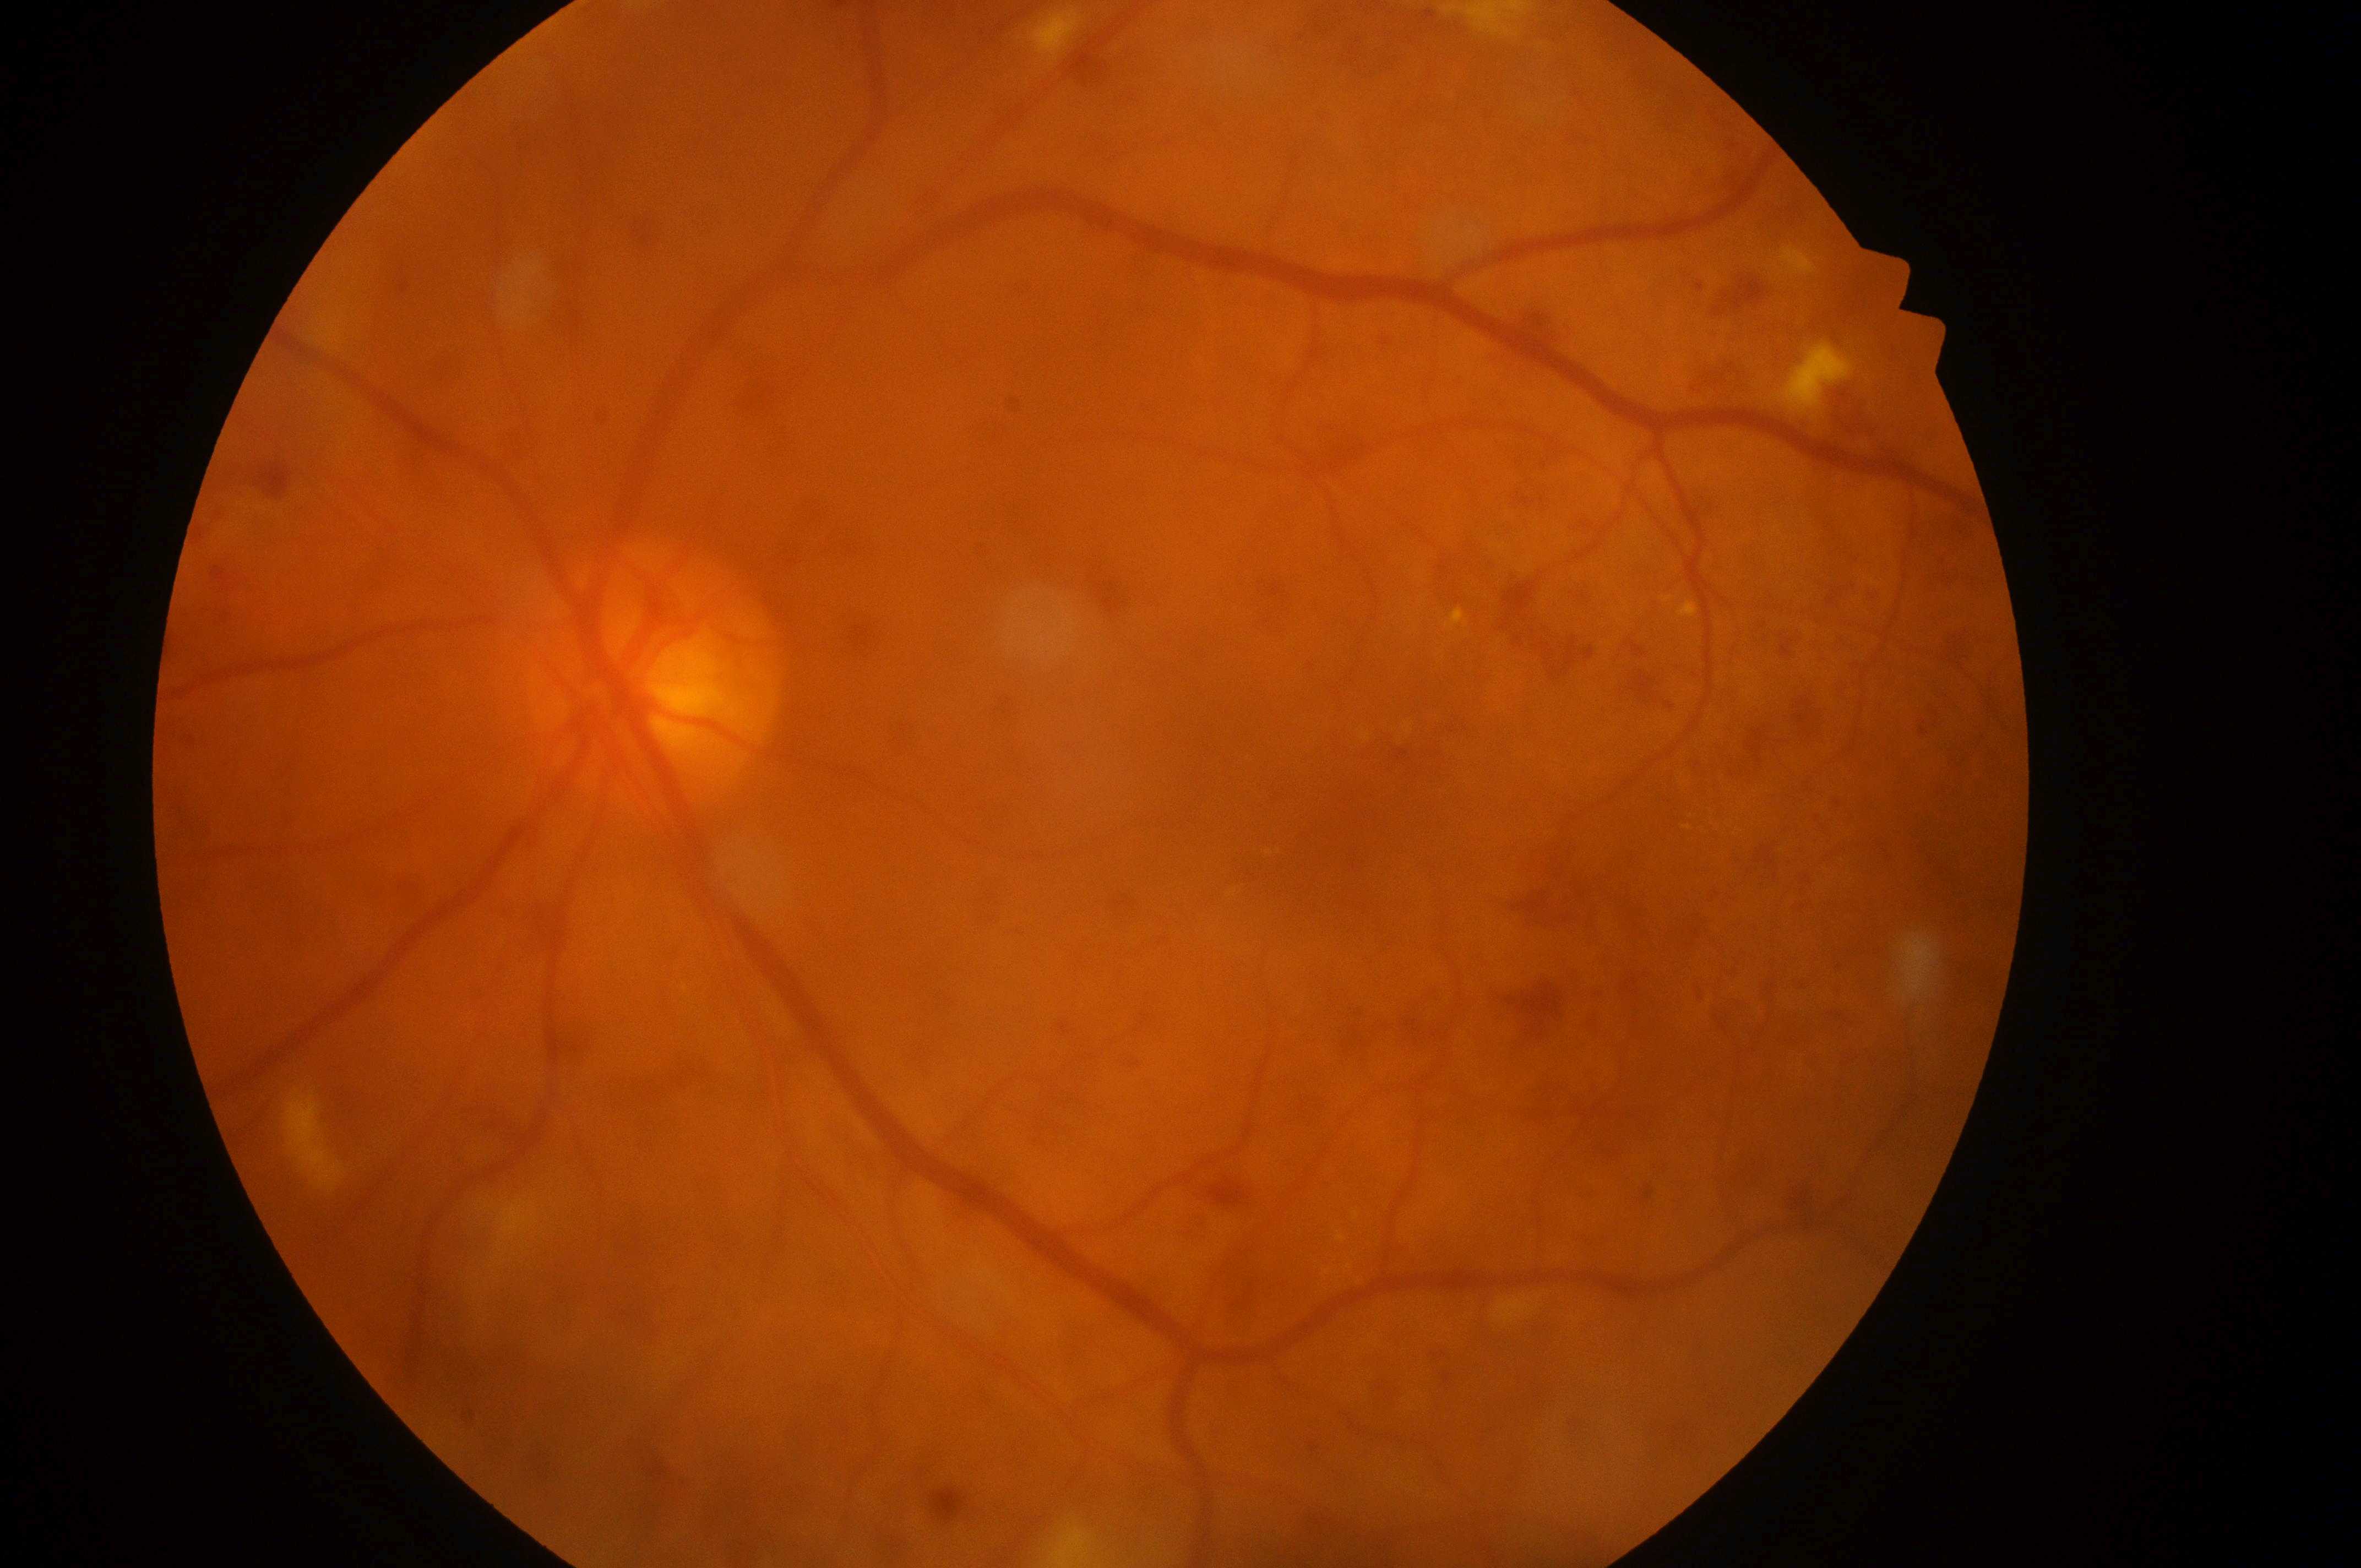 DR is severe NPDR (grade 3). Optic disc center located at (x: 651, y: 693). Eye: oculus sinister. Fovea: (x: 1332, y: 839). DME grade: high risk (2).